45° field of view — 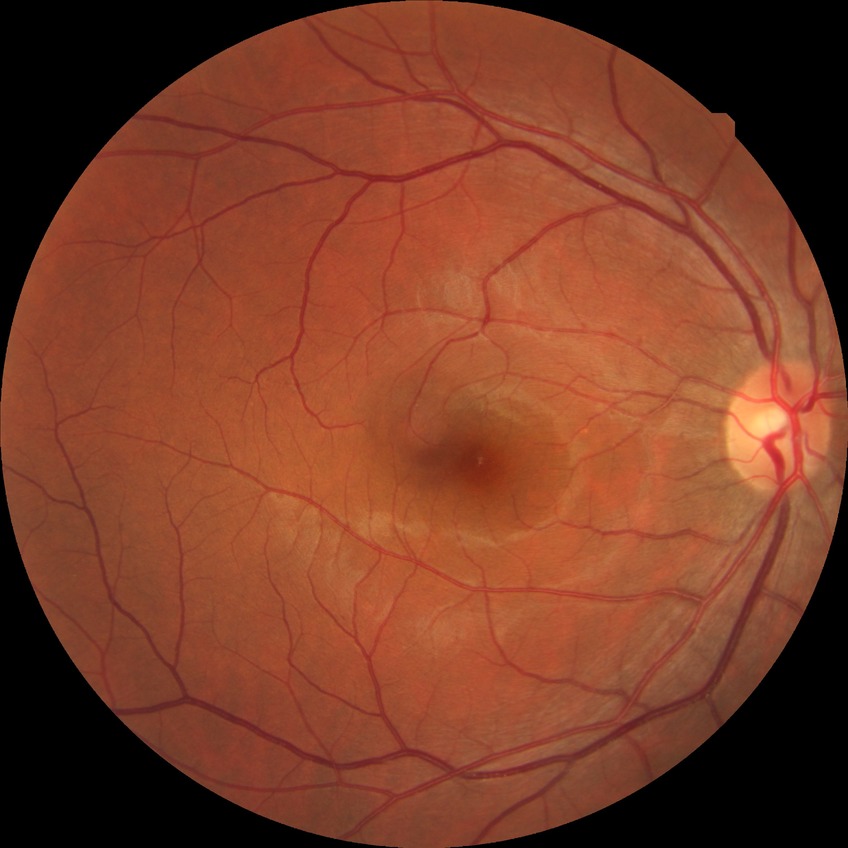 Diabetic retinopathy (DR): no diabetic retinopathy (NDR).